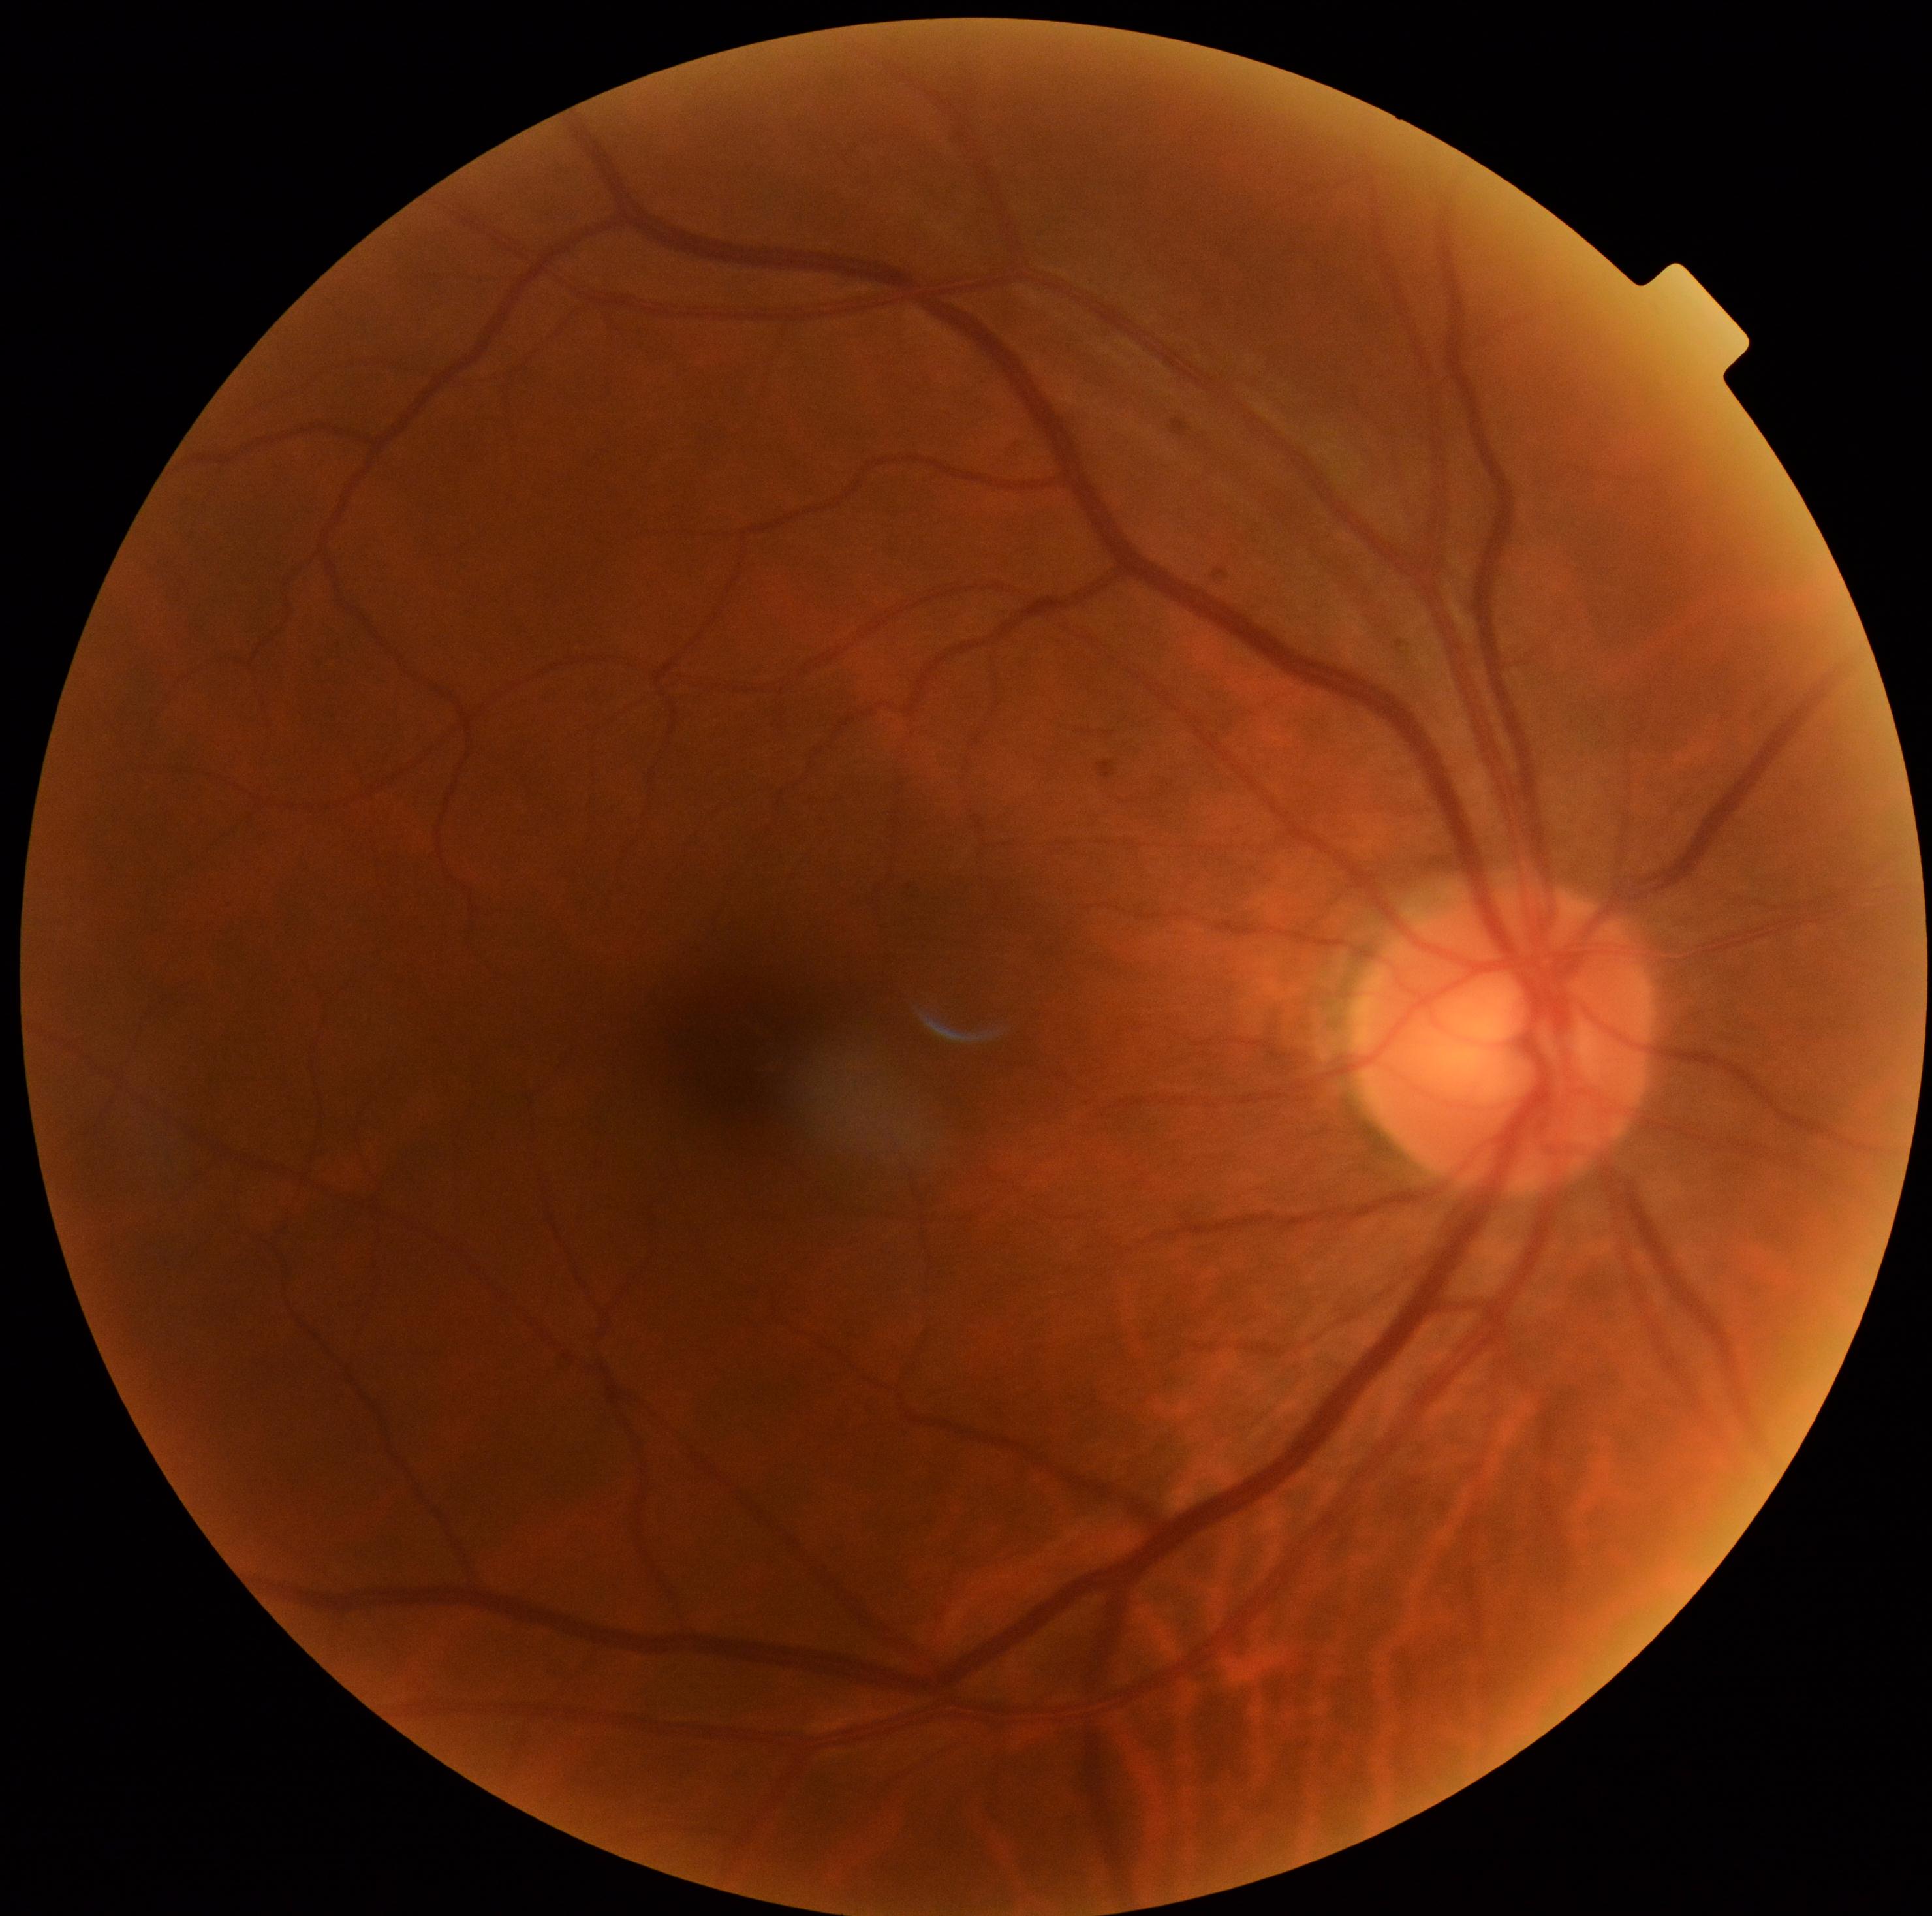

dr_grade: no apparent diabetic retinopathy (0)